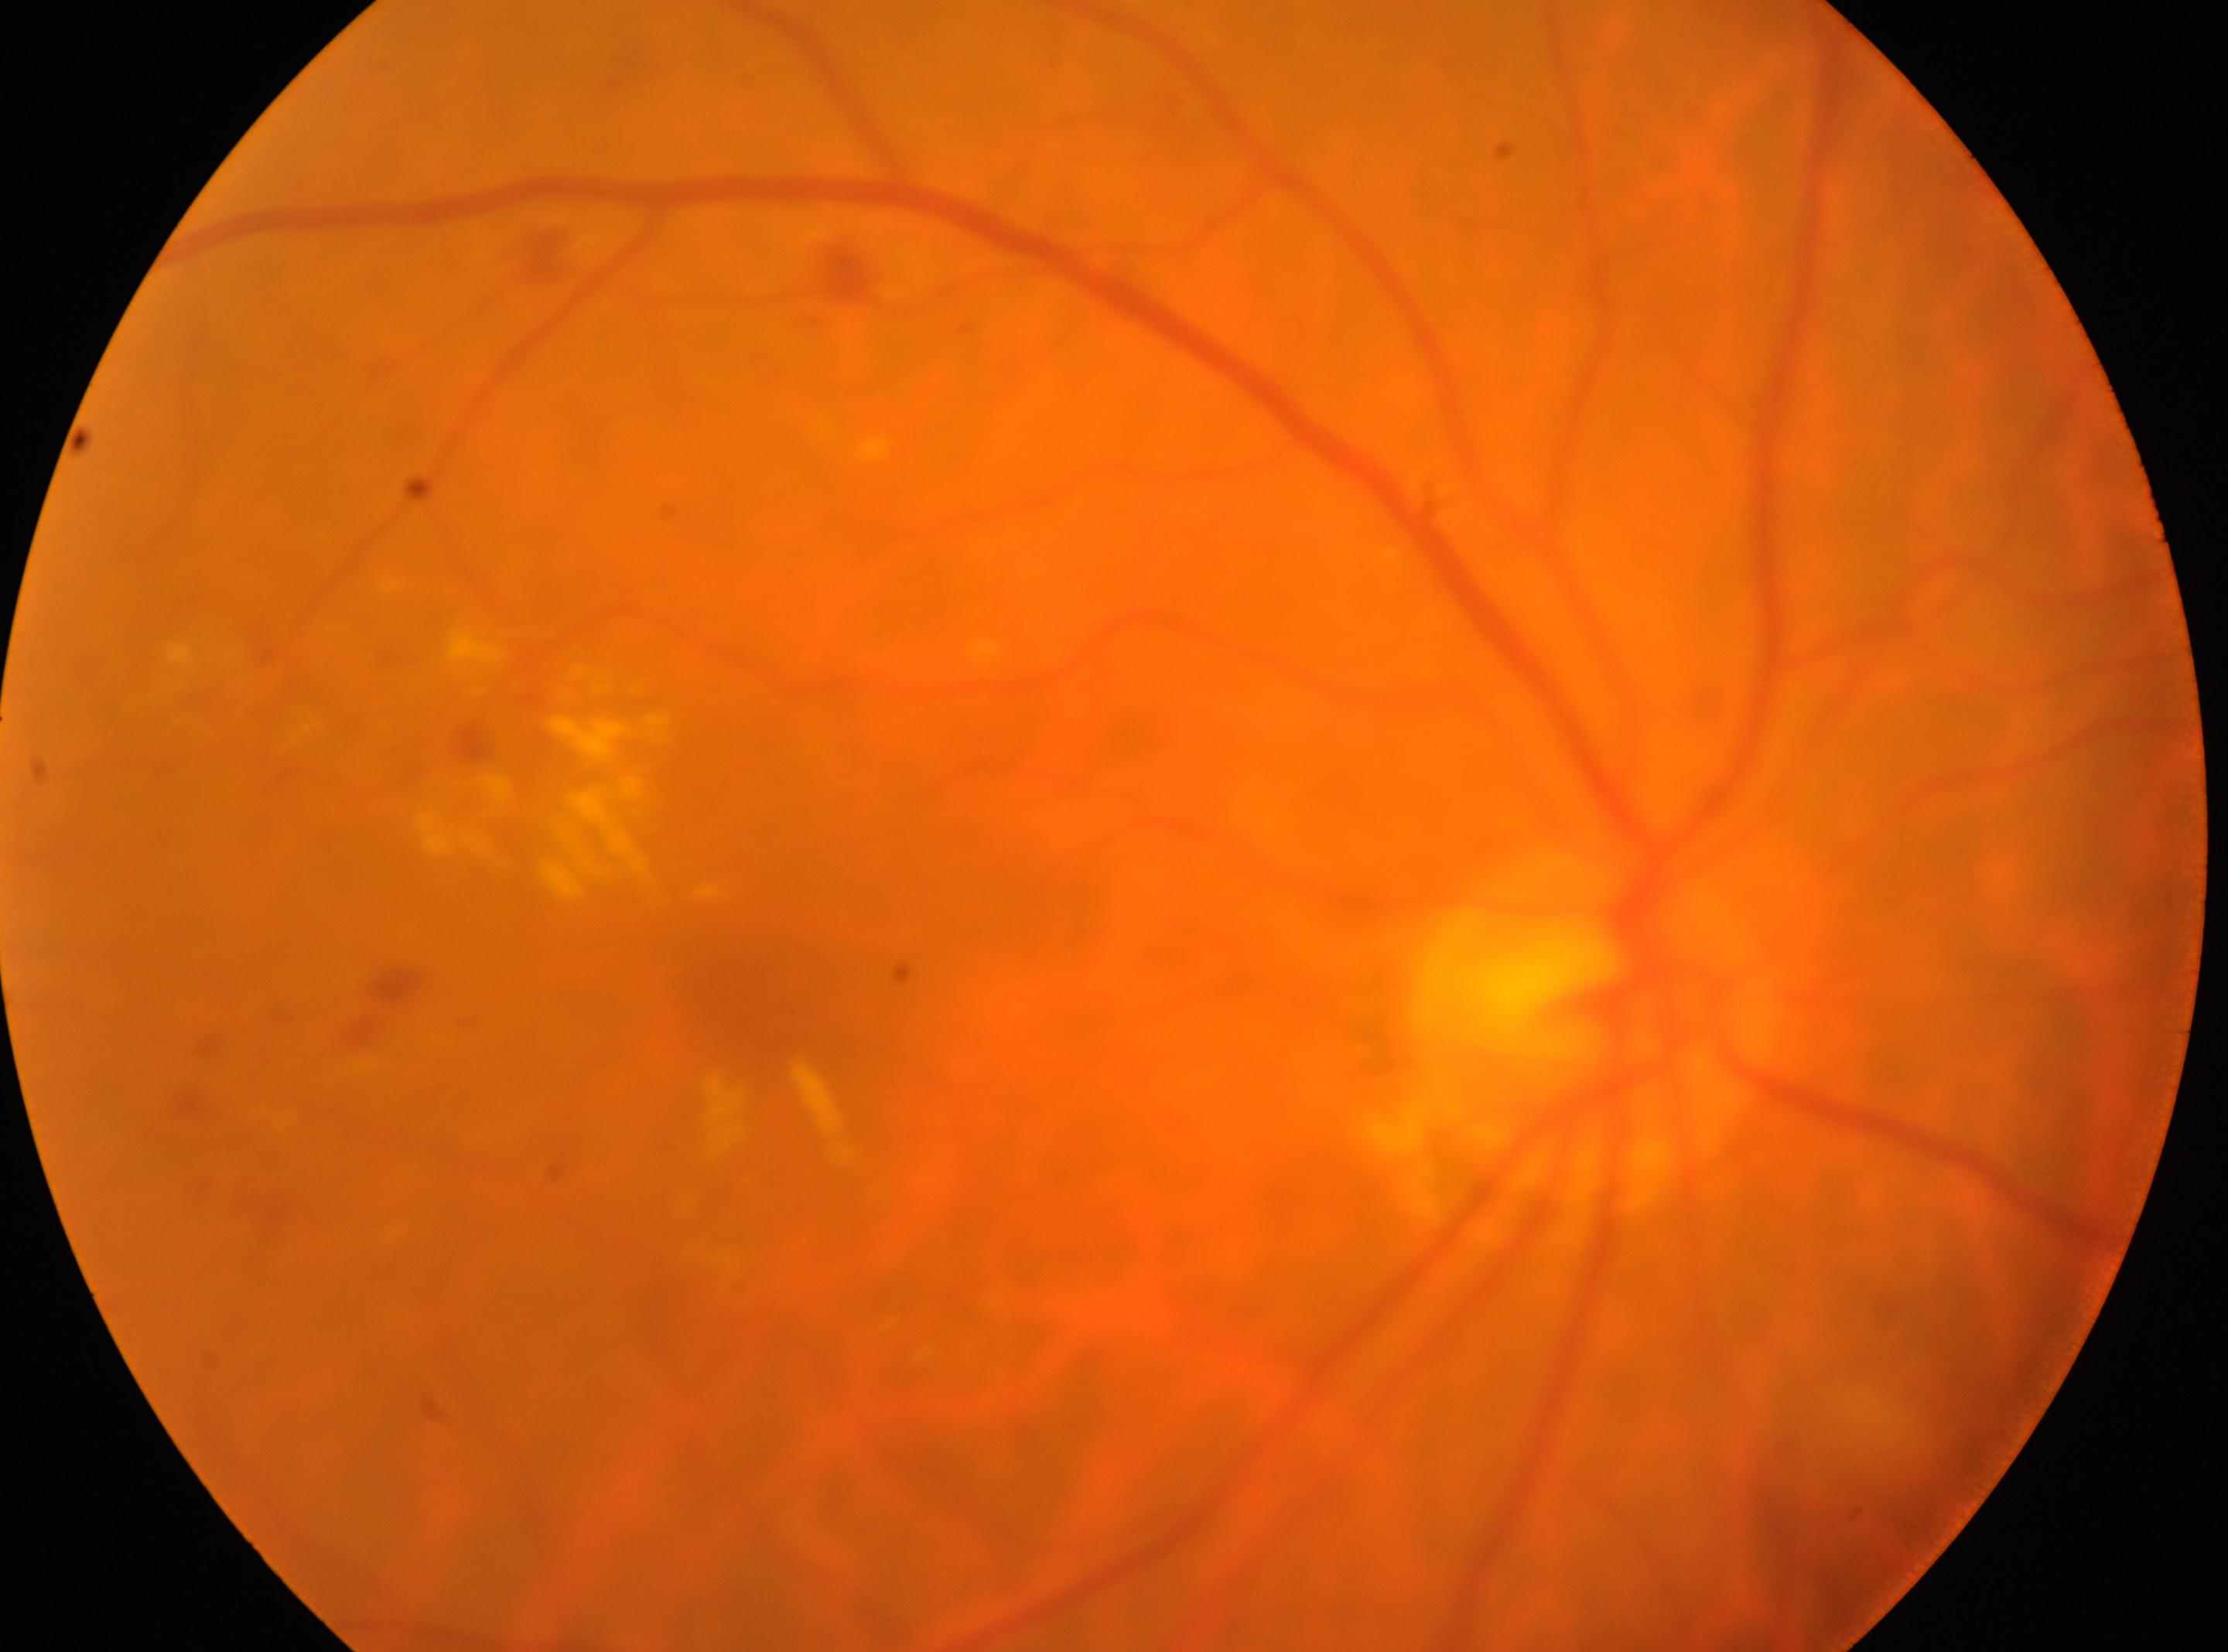 laterality: right eye | disc center: 1589, 1029 | foveal center: 749, 1007 | DR severity: 2/4.